Optic nerve head photograph, mydriatic.
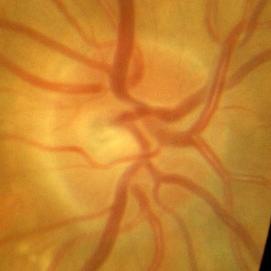

No evidence of glaucoma.